Davis DR grading: 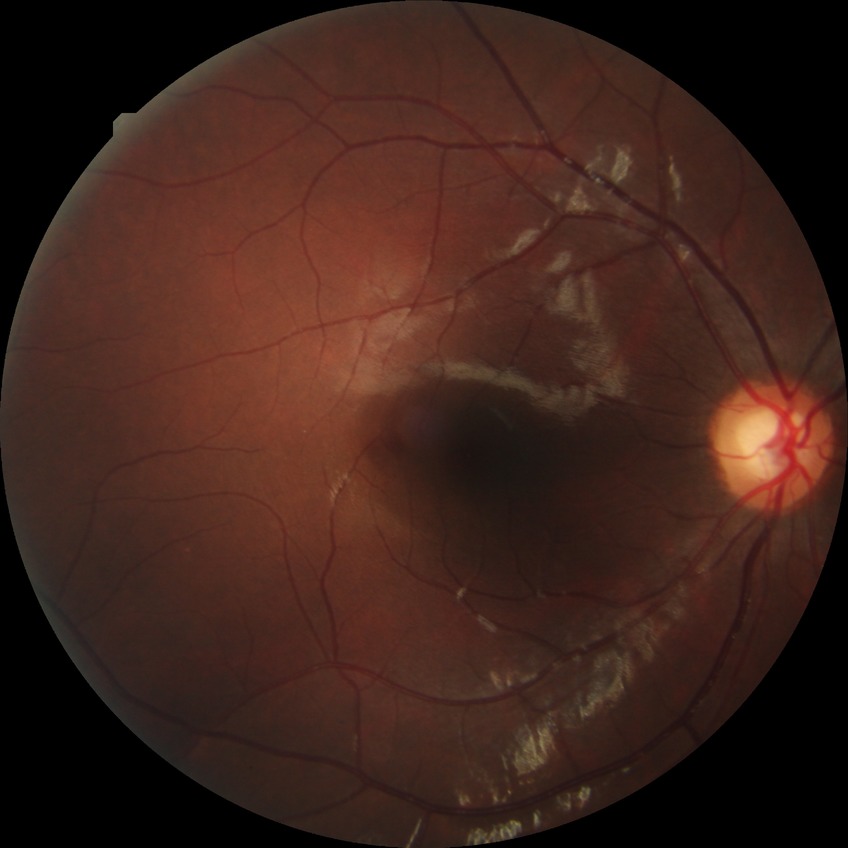 diabetic retinopathy (DR)=NDR (no diabetic retinopathy).